Acquired with a Topcon TRC-50DX — 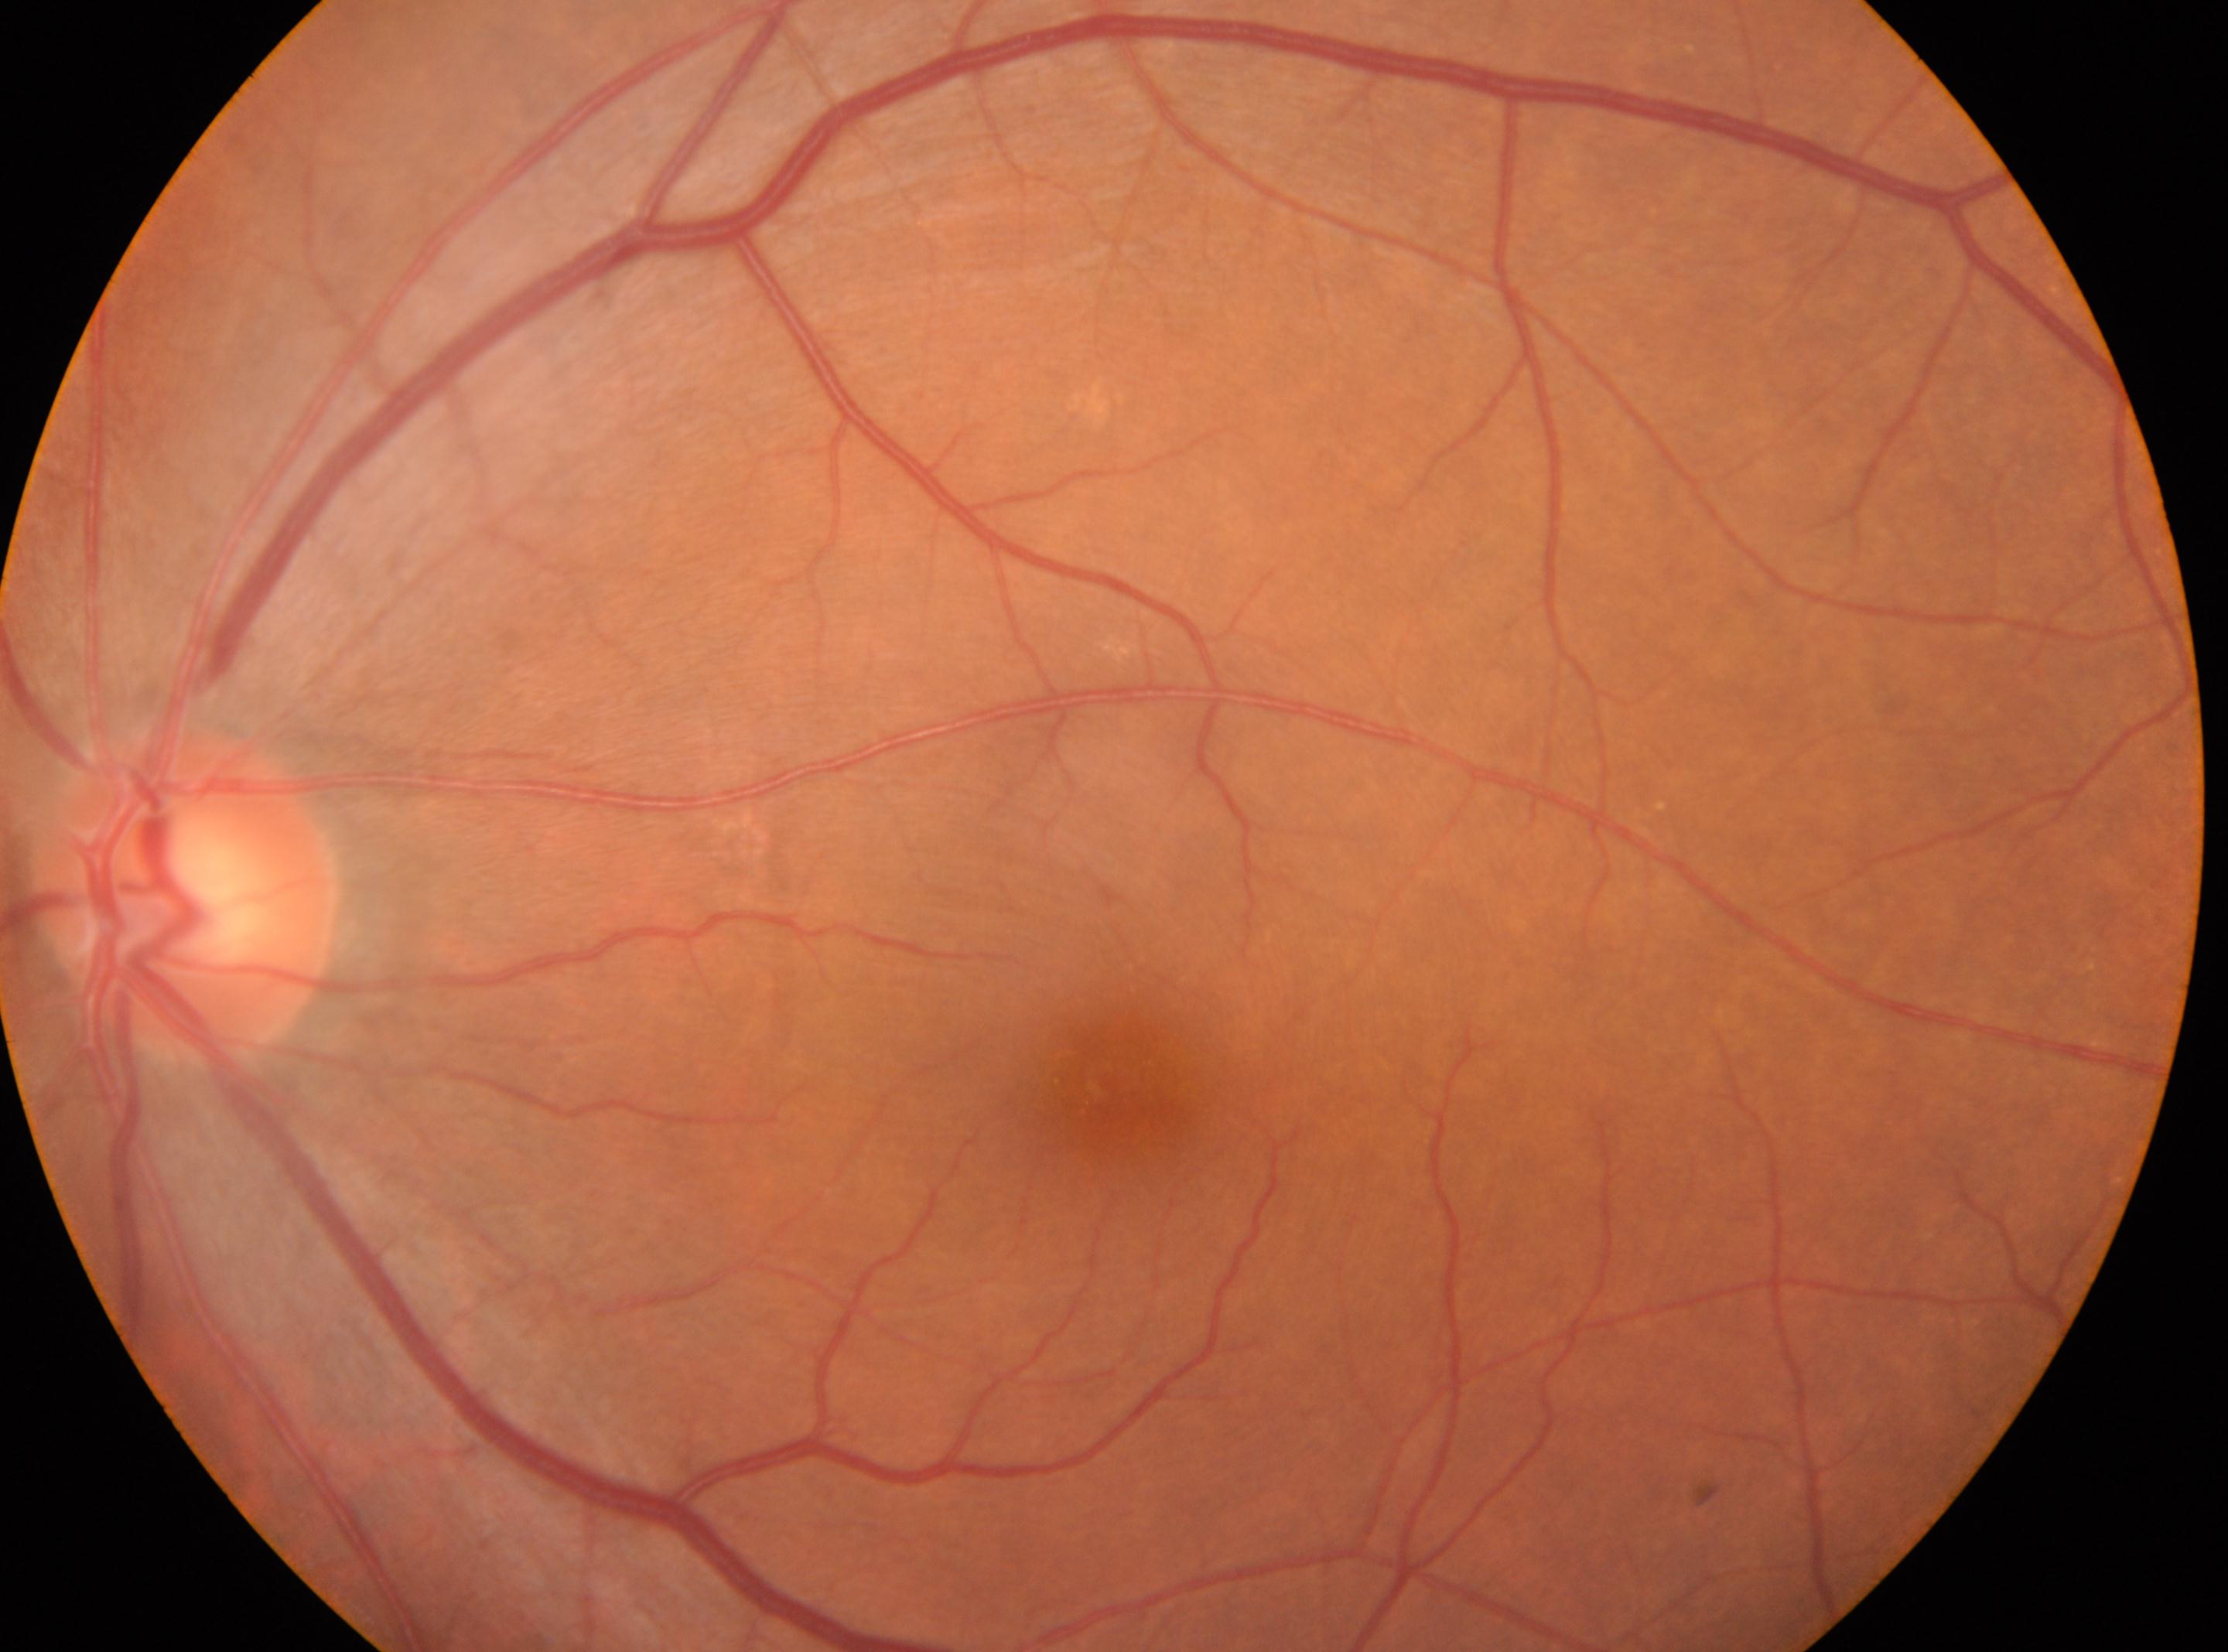

Macular center: 1111, 1078.
Imaged eye: left eye.
Diabetic retinopathy severity: no apparent retinopathy (grade 0).
Optic disc center: 187, 896.